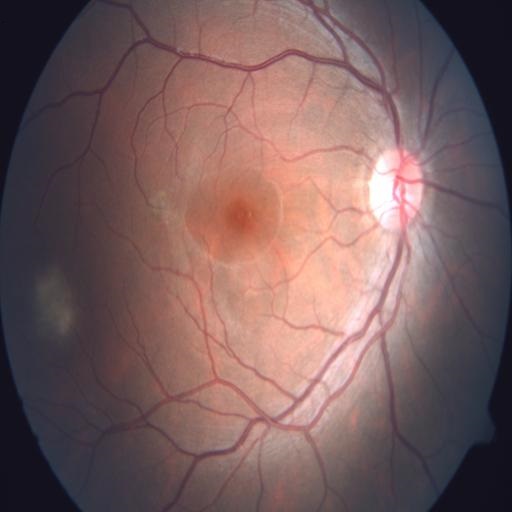

Fundus appearance consistent with central serous retinopathy.